Clarity RetCam 3, 130° FOV. 640x480. Pediatric retinal photograph (wide-field) — 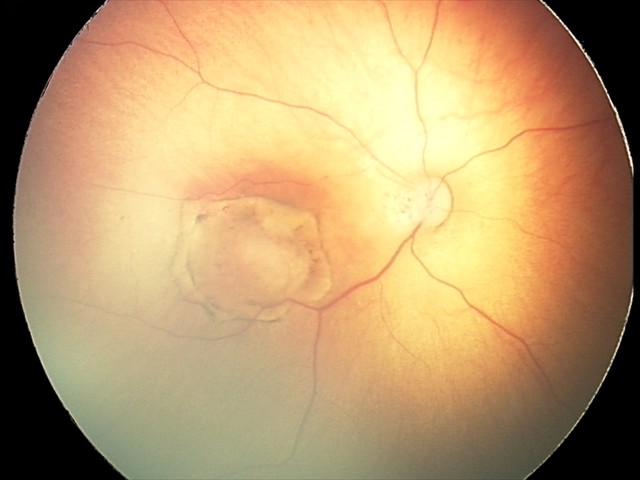 Screening series with toxoplasmosis chorioretinitis.